1240x1240; Phoenix ICON wide-field infant fundus image: 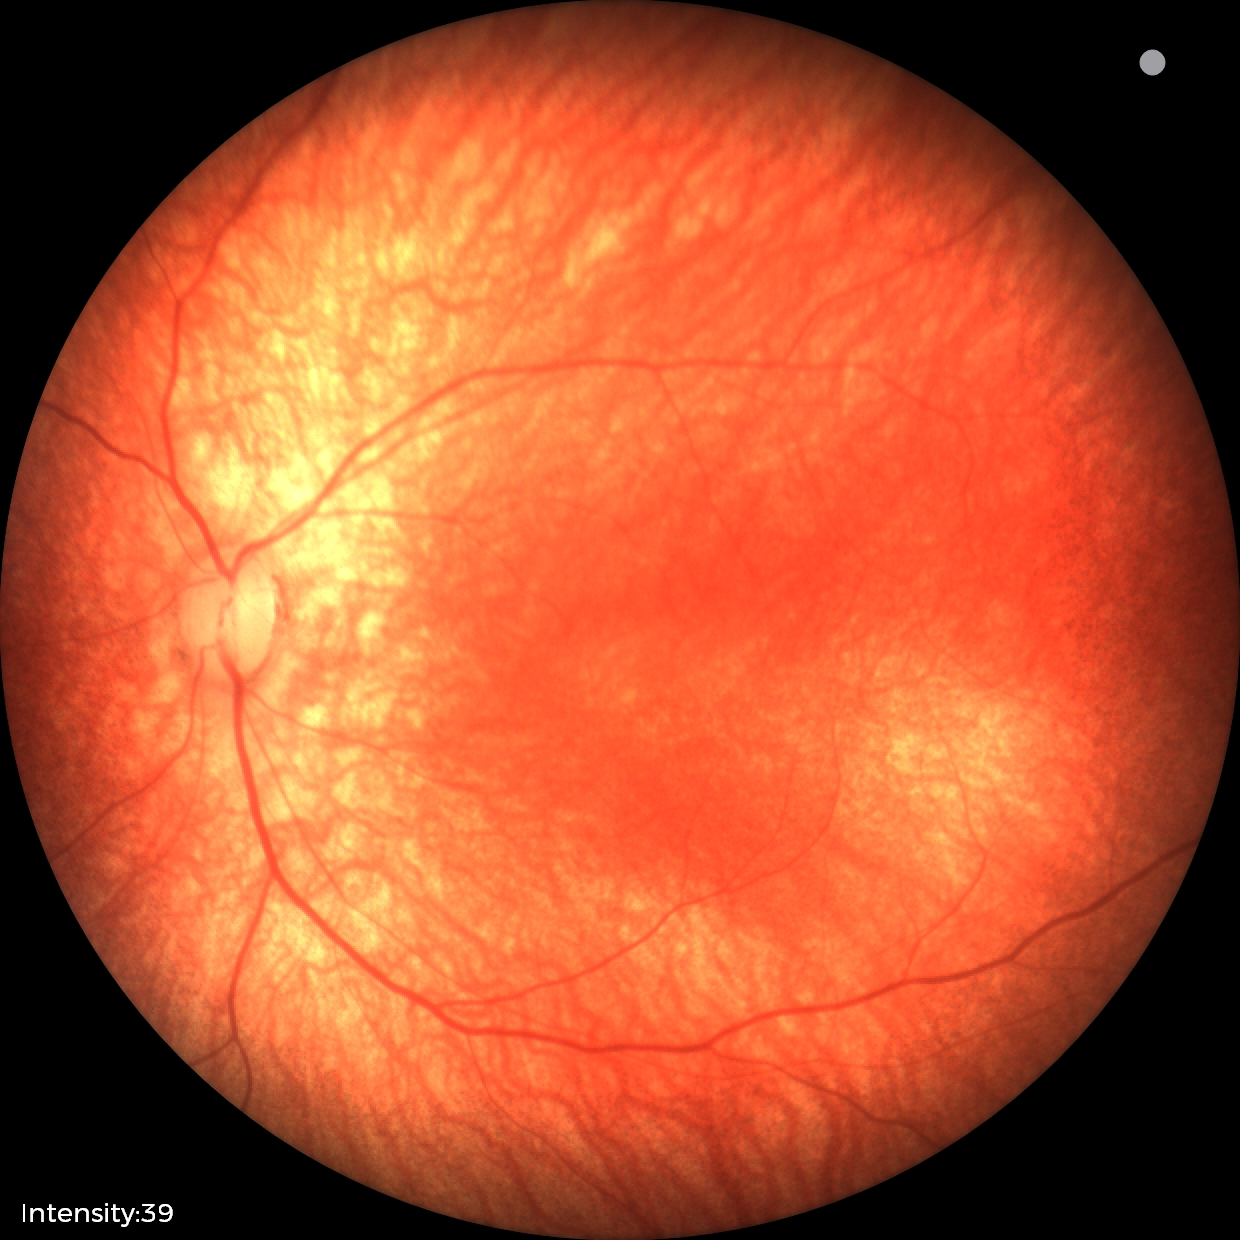
Diagnosis: no pathology identified